45° field of view. Image size 2352x1568:
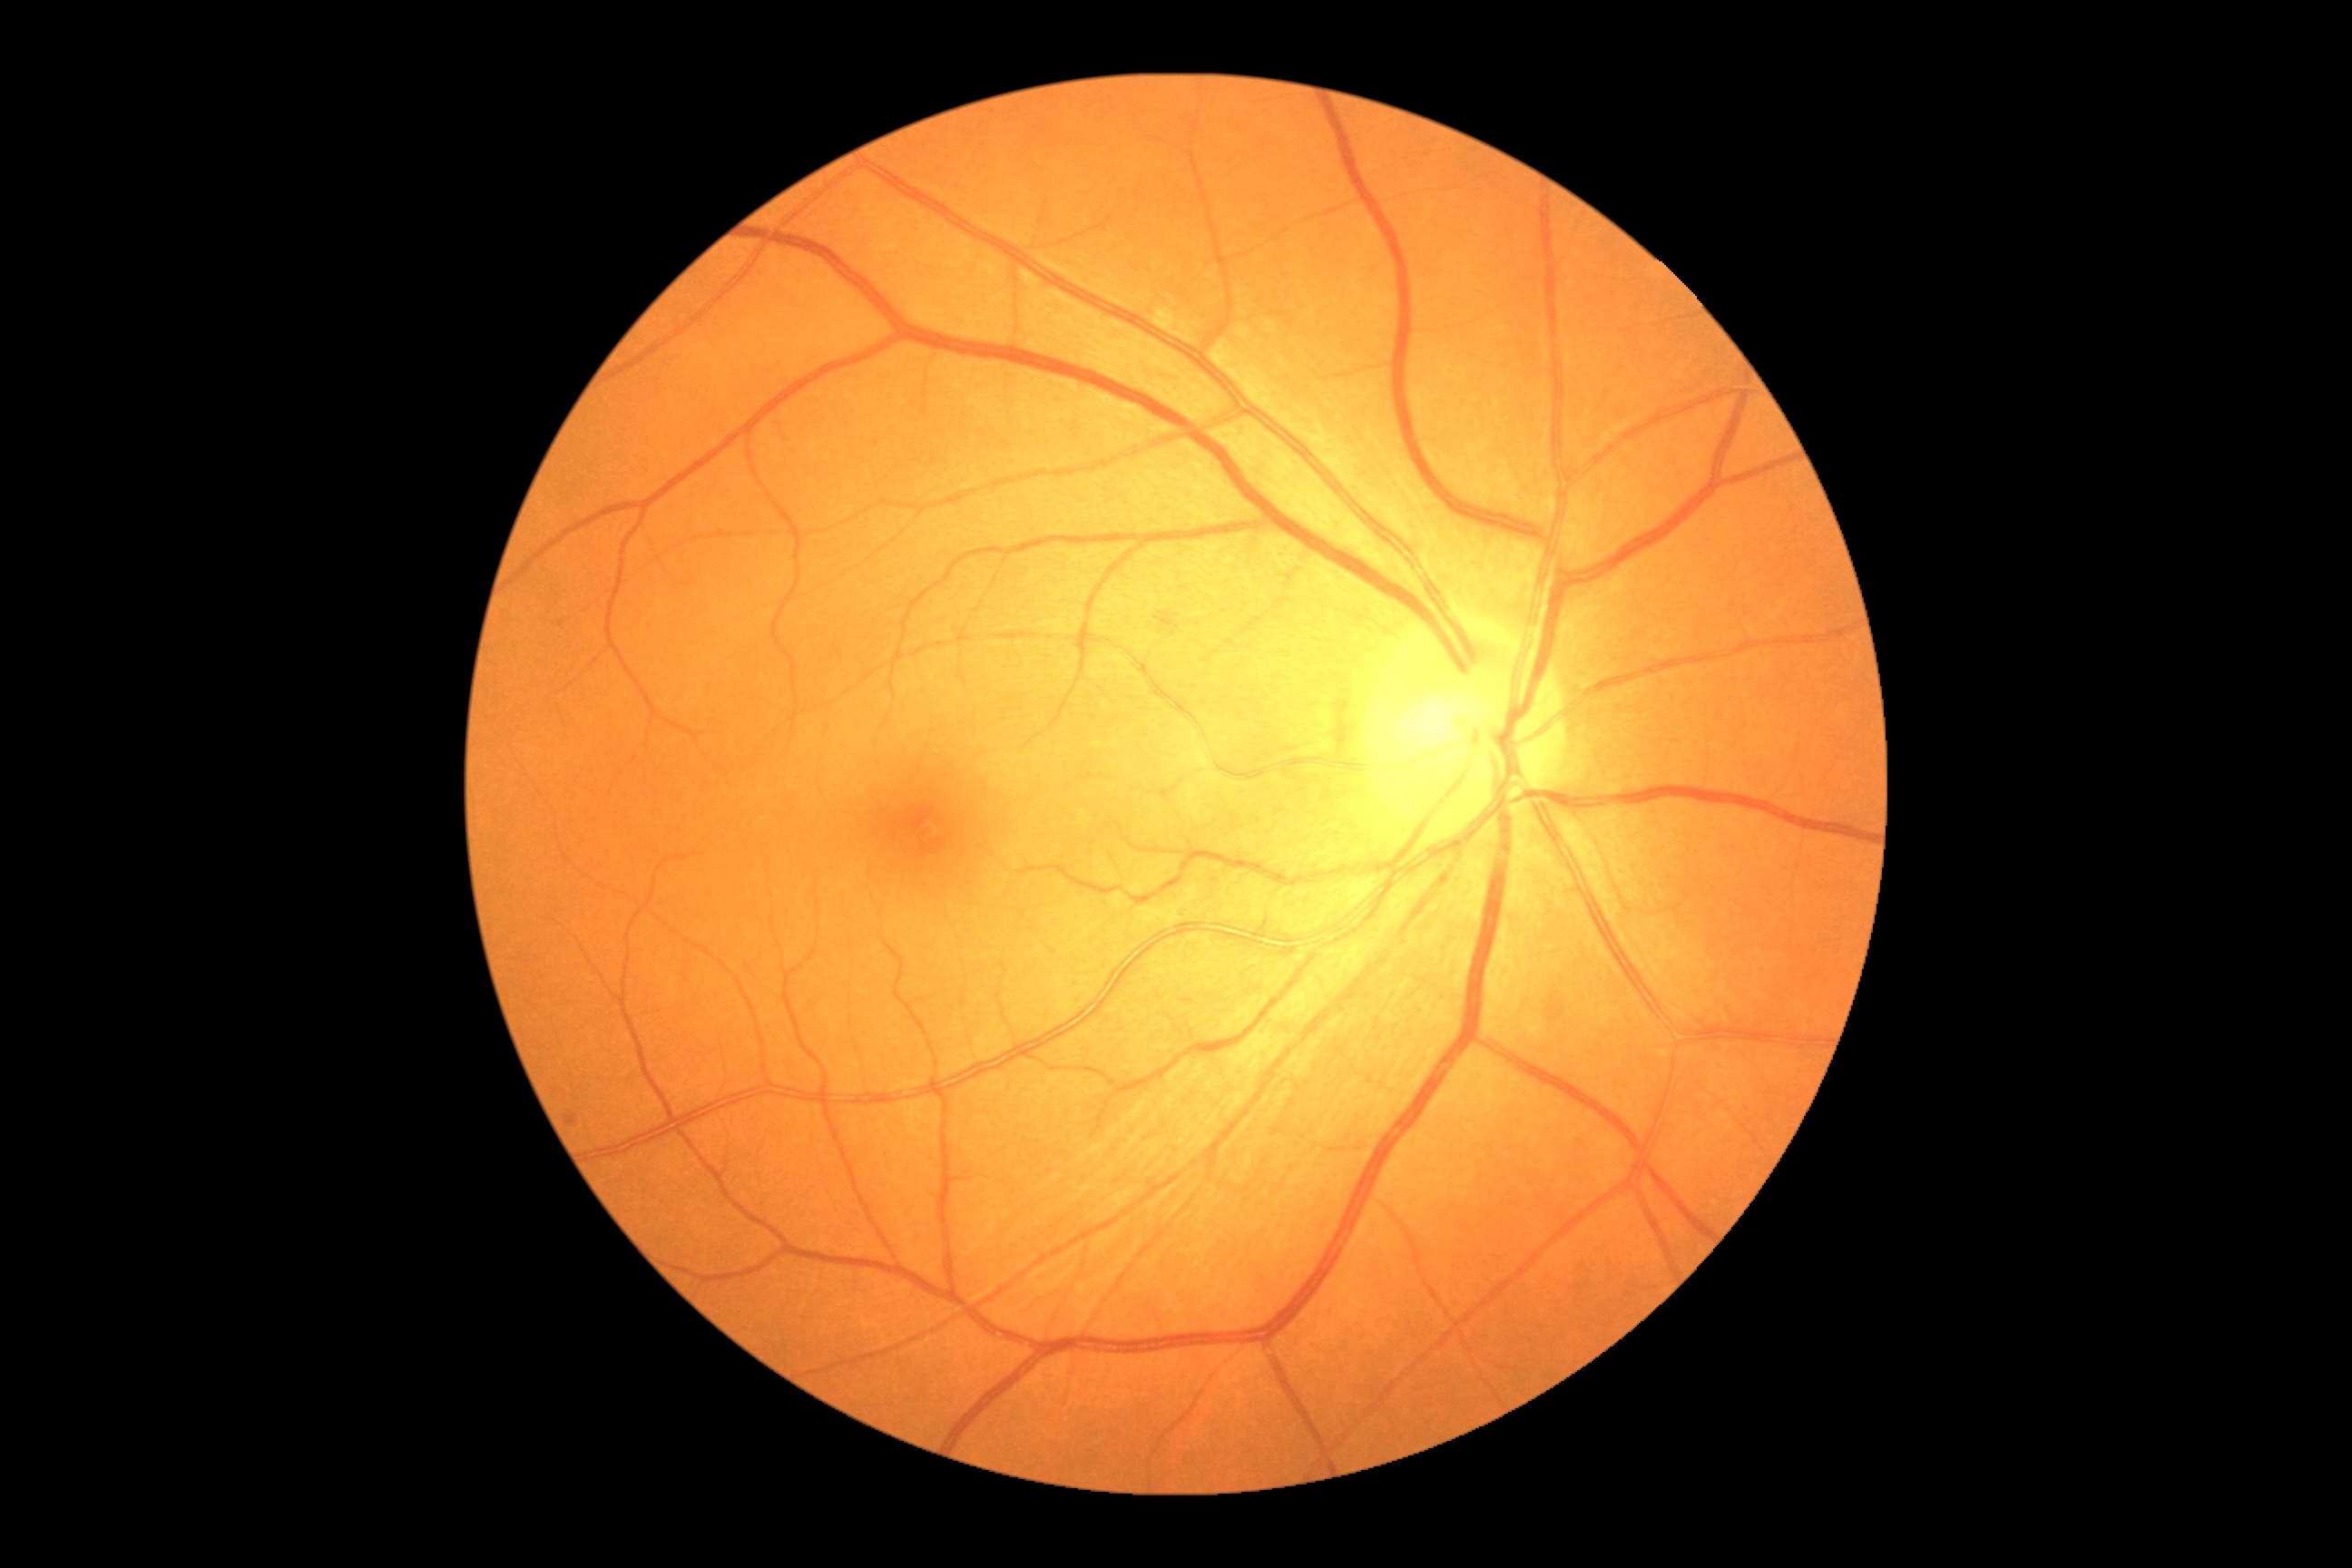 Annotations:
– diabetic retinopathy (DR) — moderate non-proliferative diabetic retinopathy (grade 2) — more than just microaneurysms but less than severe NPDR